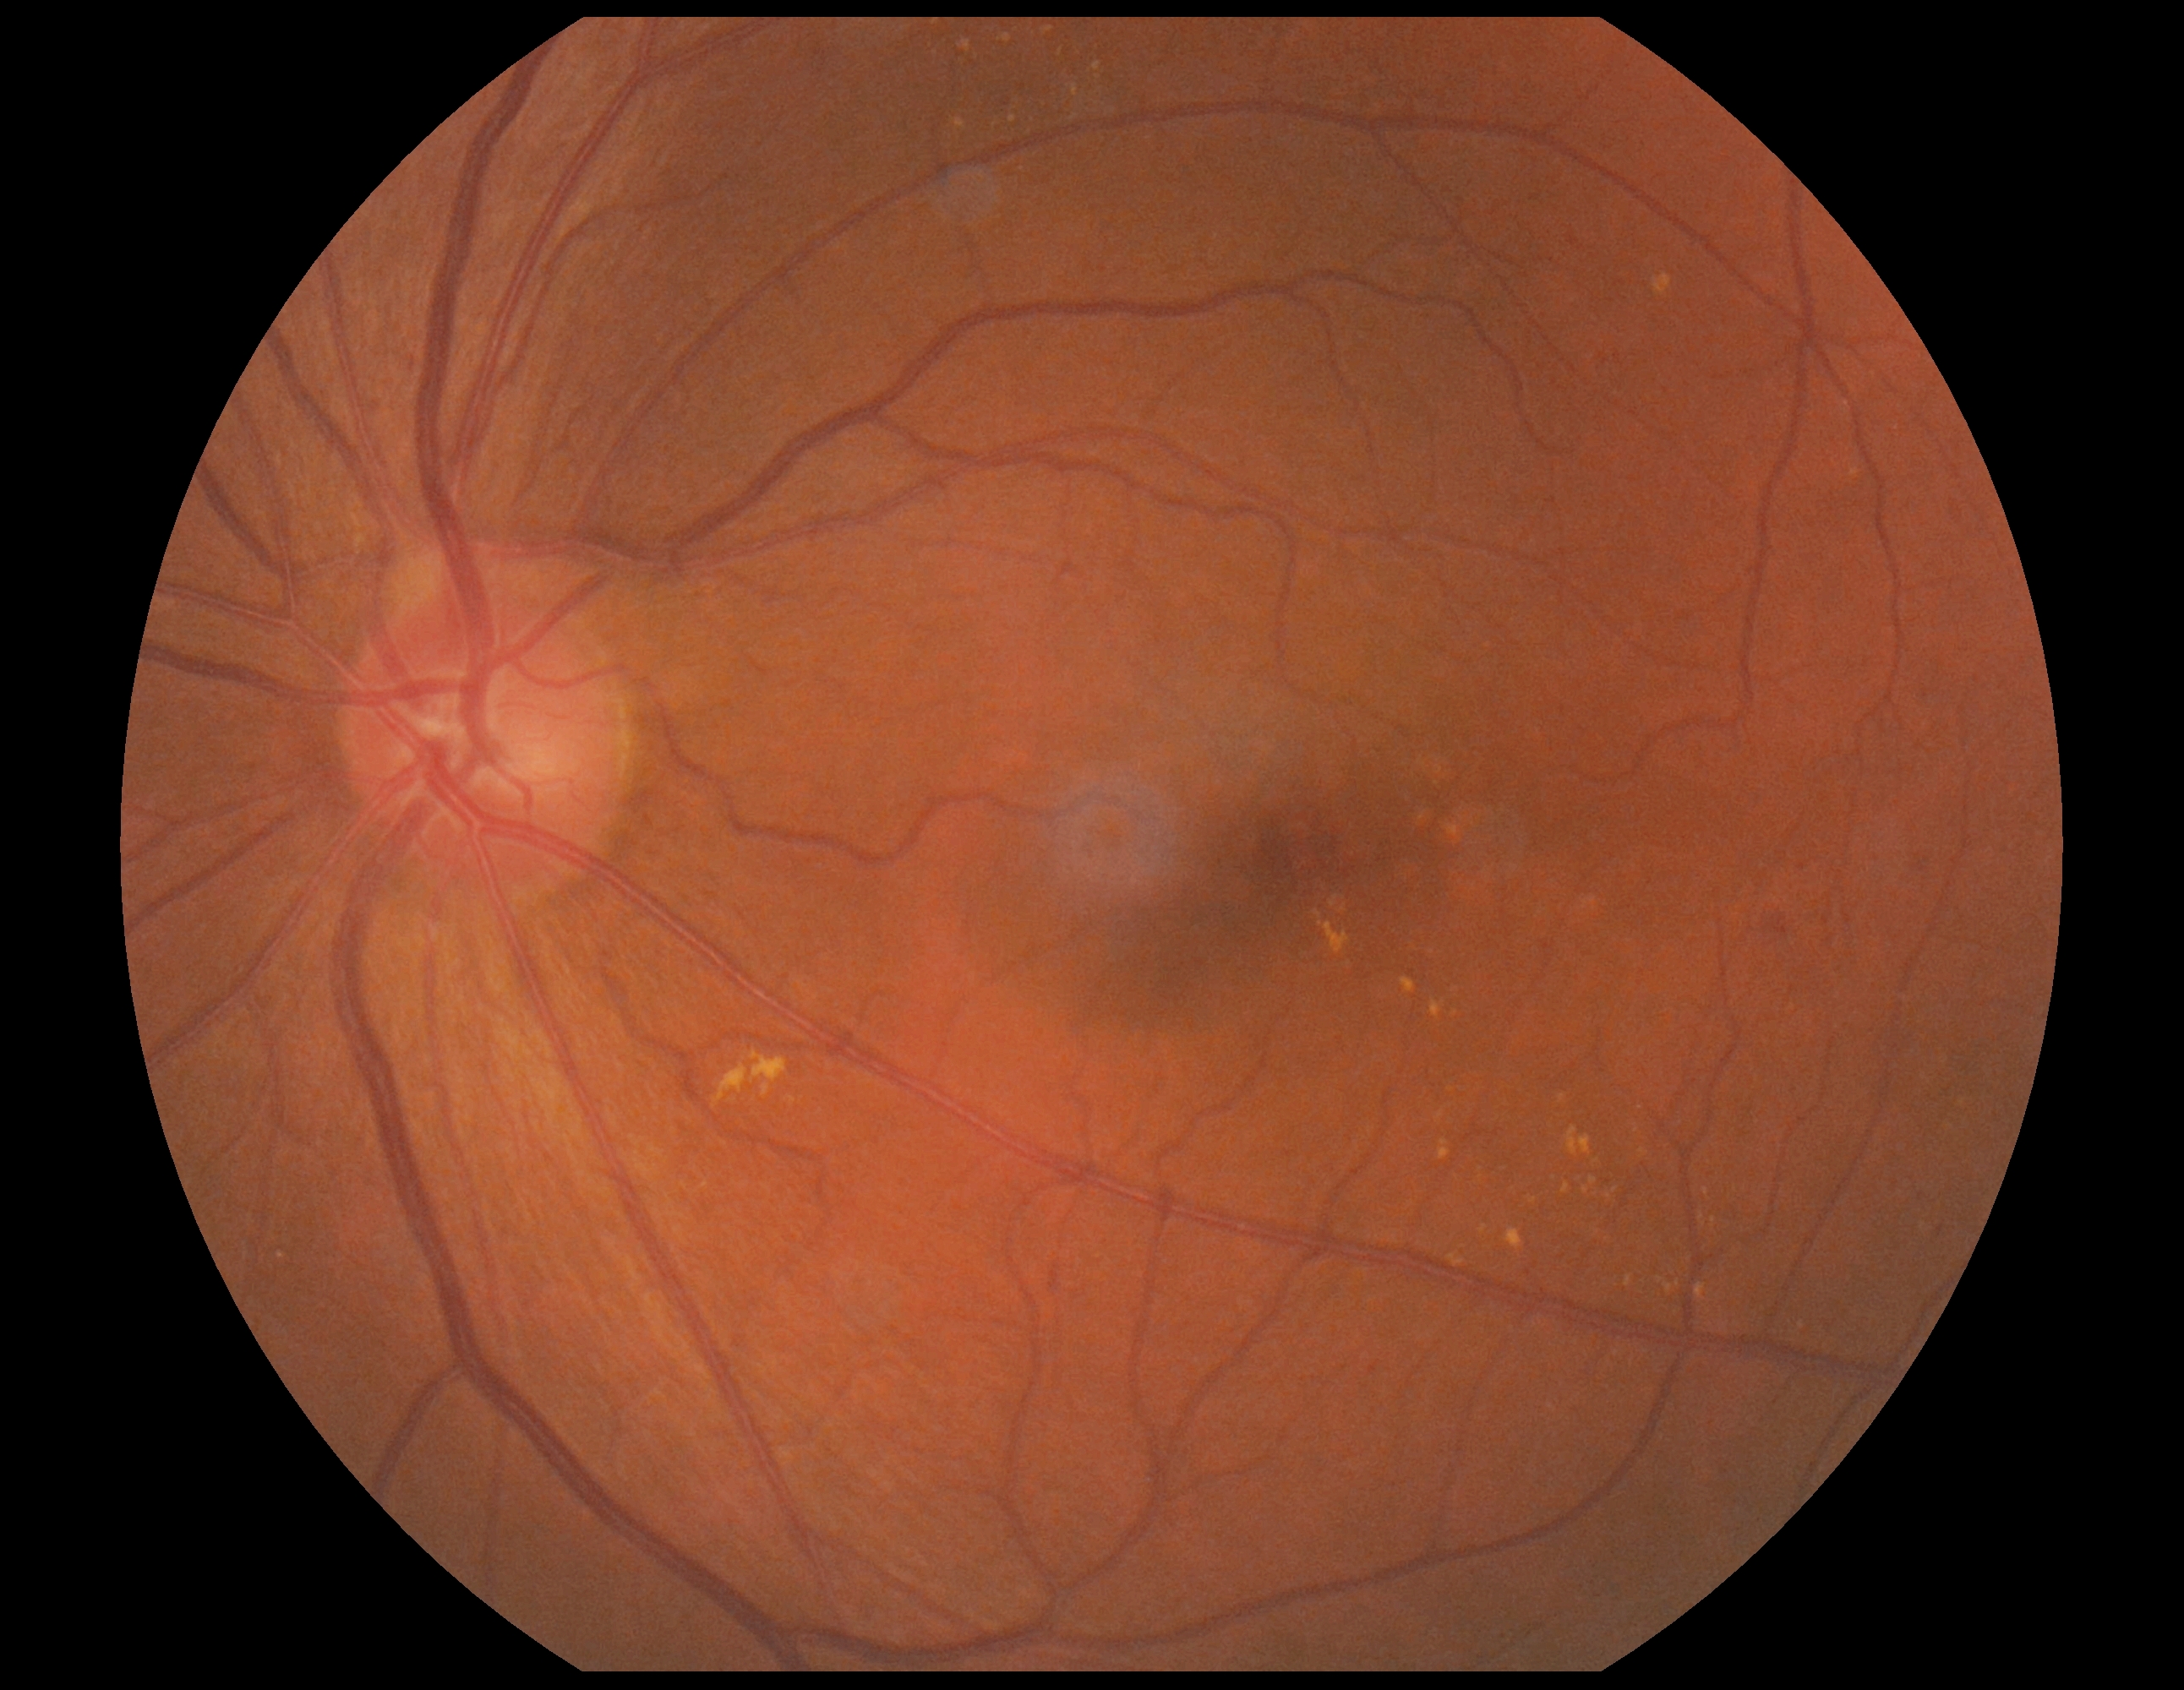   dr_grade: 2 (moderate NPDR)